Ultra-widefield fundus photograph:
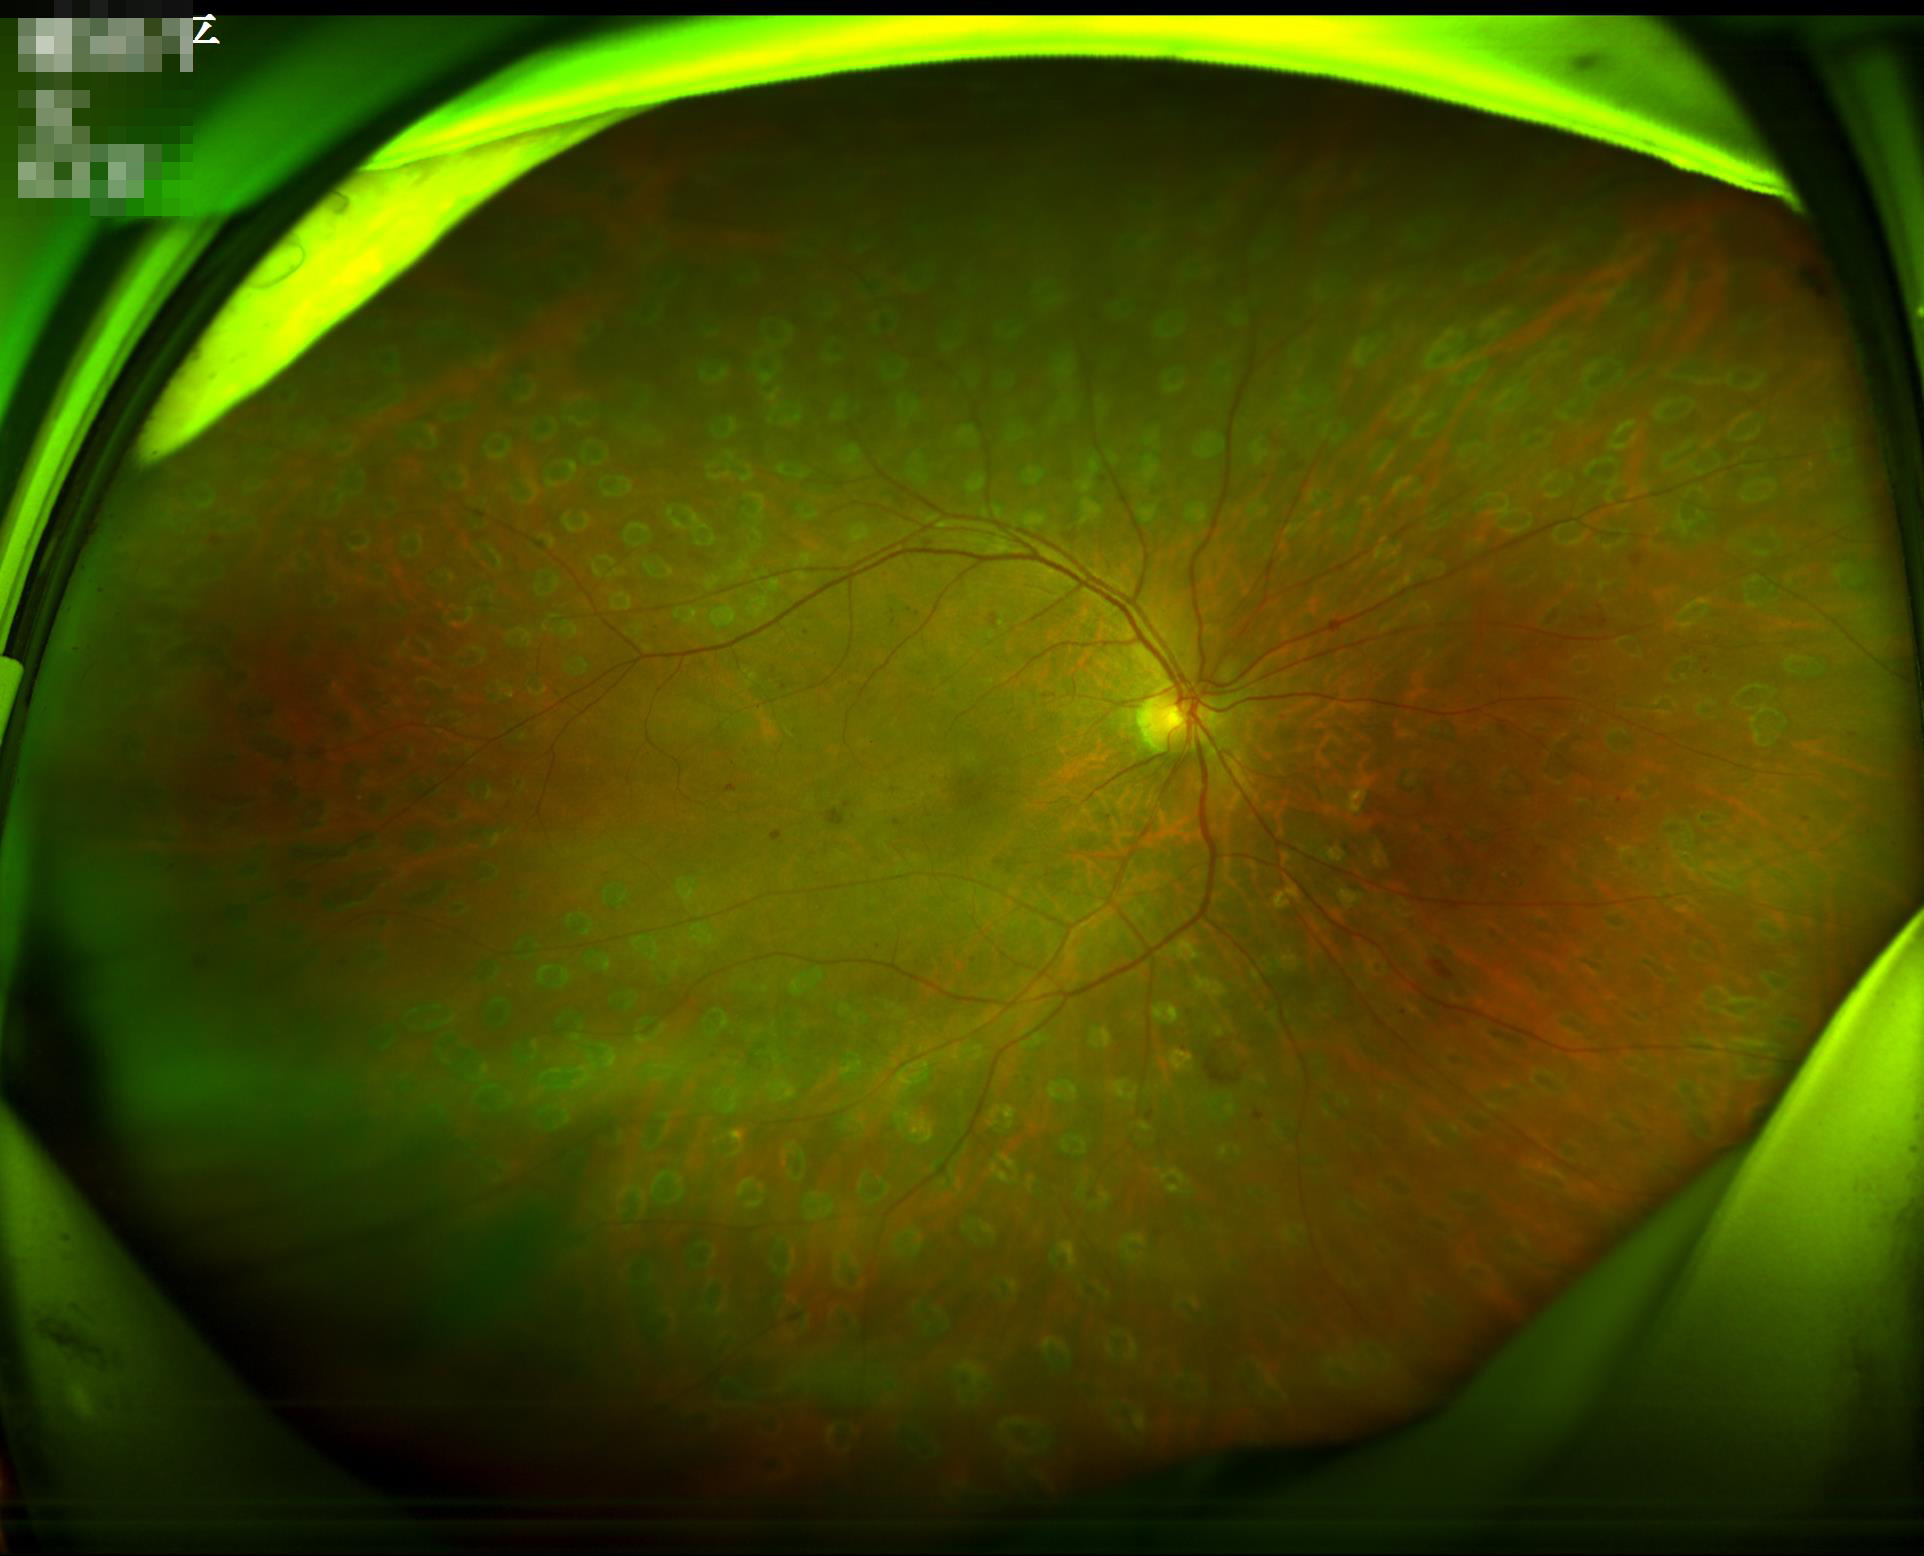 Image quality: contrast: satisfactory; illumination: adequate; overall: acceptable; clarity: good.